Wide-field fundus photograph from neonatal ROP screening; camera: Natus RetCam Envision (130° FOV); 1440 by 1080 pixels: 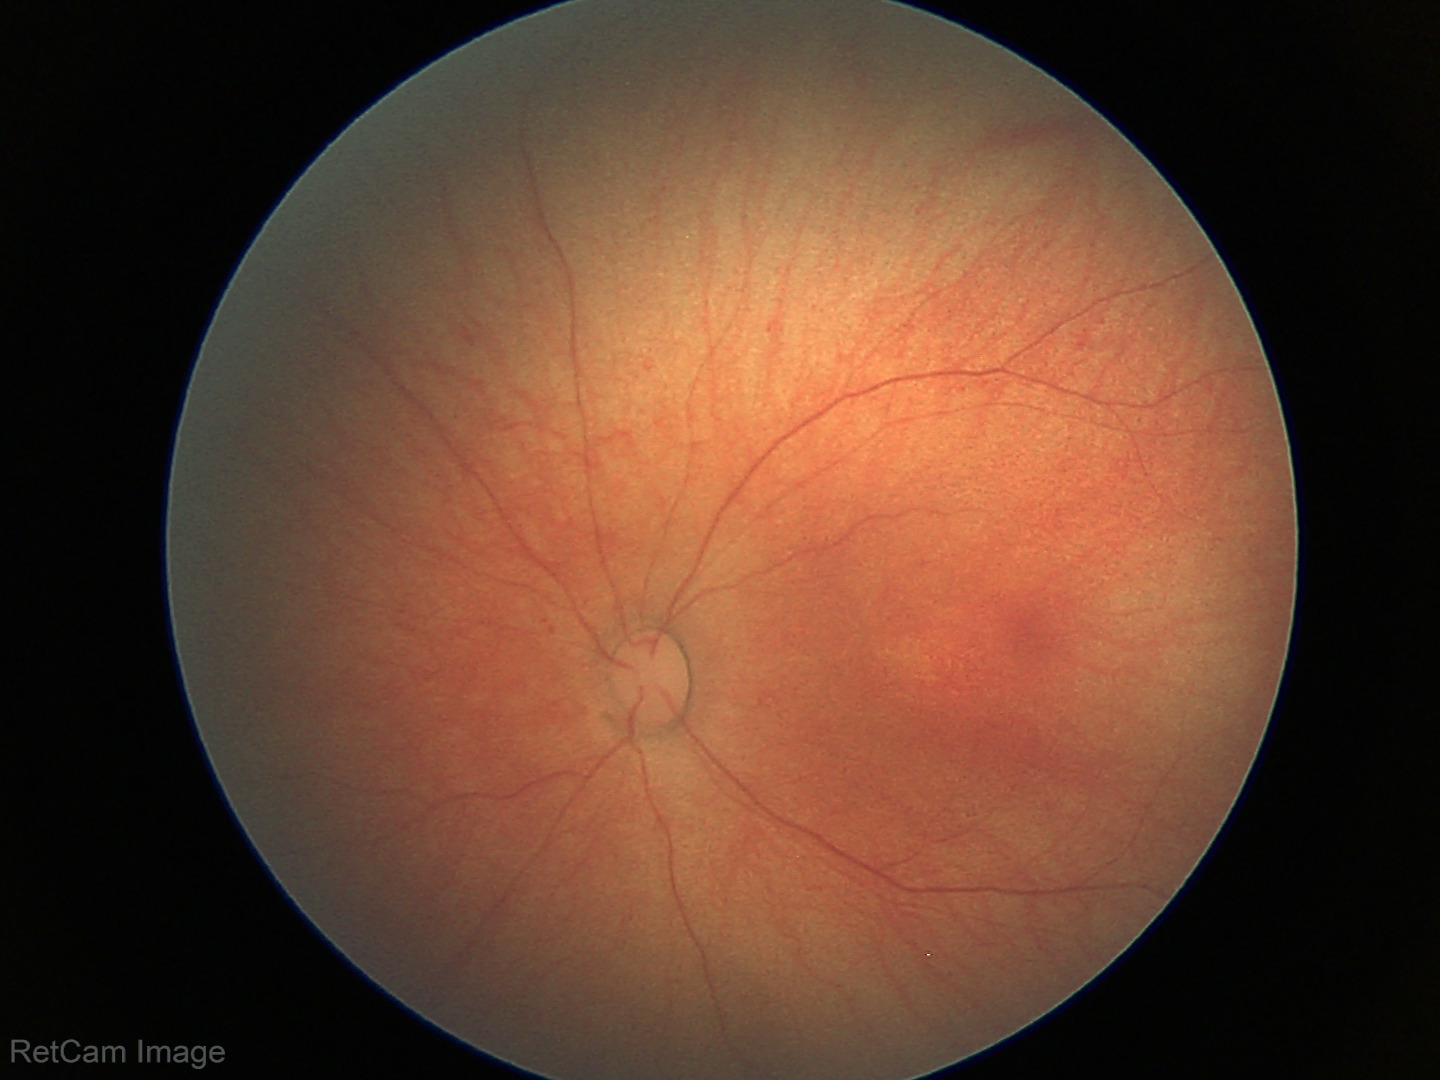 Diagnosis: no abnormalities.